Color fundus photograph. 50° field of view — 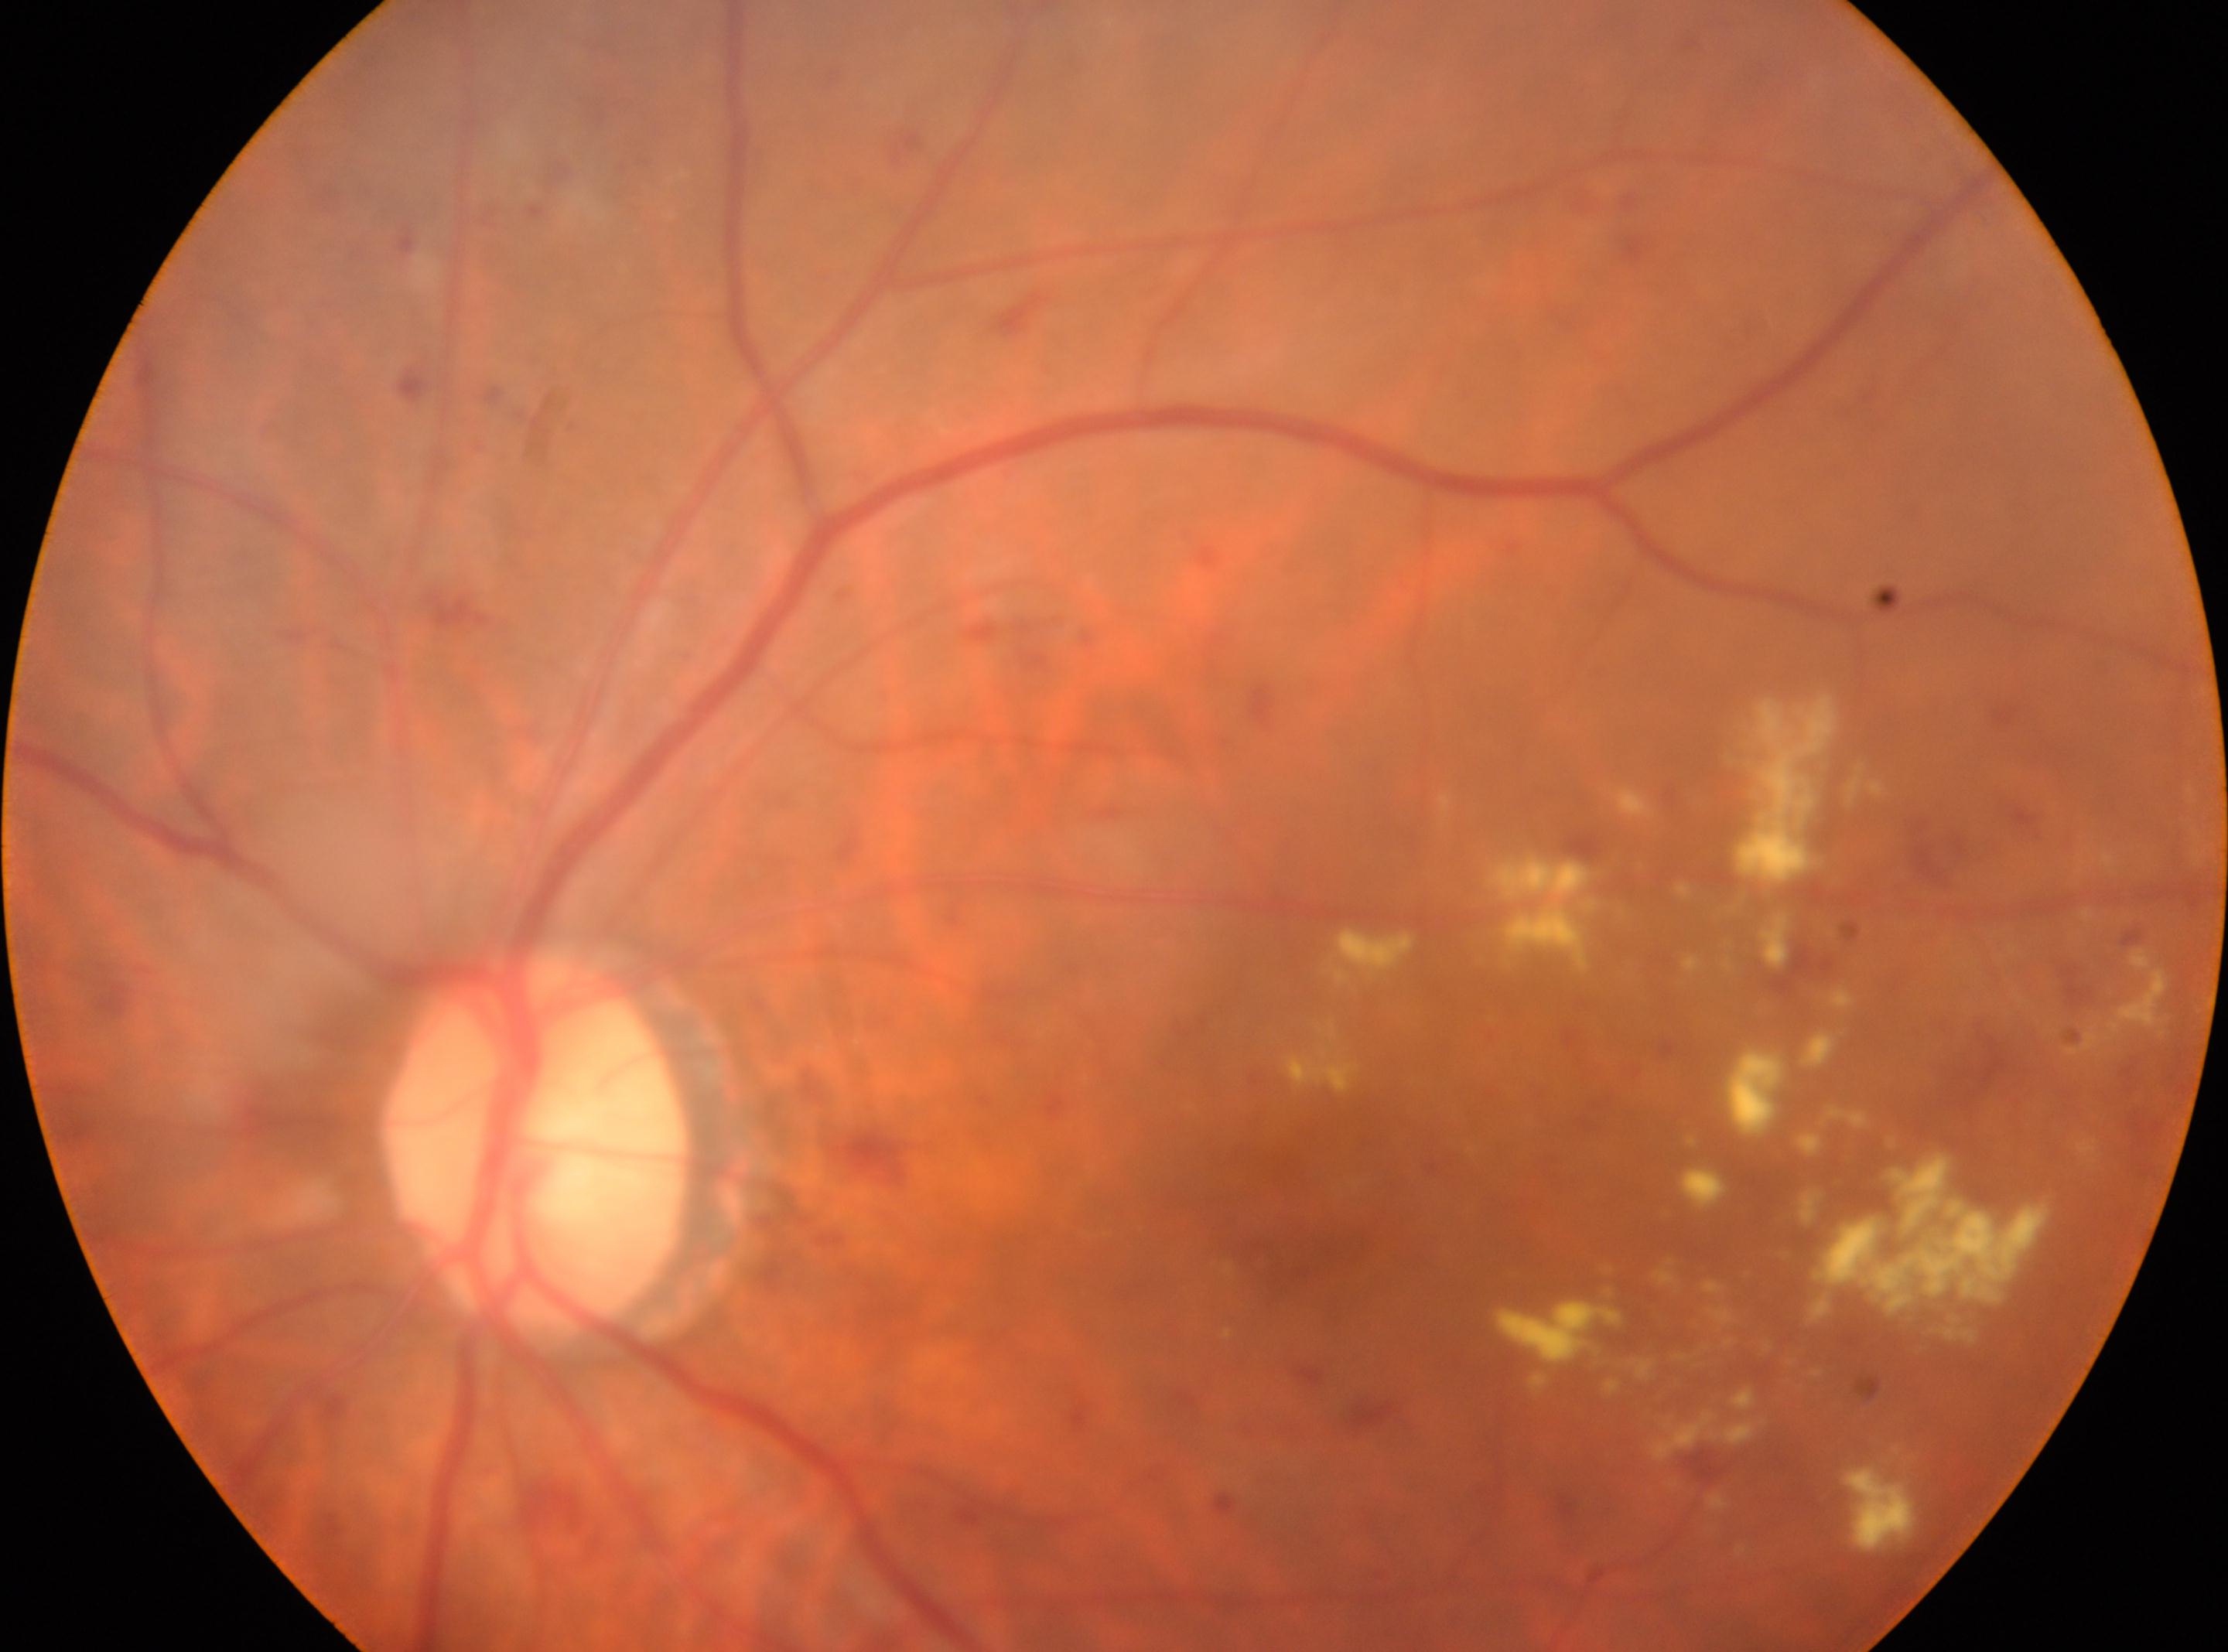
Q: Fovea center?
A: (x=1310, y=1191)
Q: Which eye is imaged?
A: left
Q: Optic disc center?
A: (x=537, y=1148)
Q: Diabetic retinopathy severity?
A: moderate NPDR (grade 2)